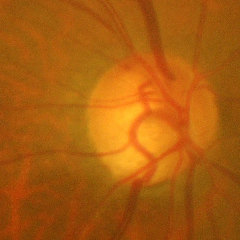
Glaucomatous optic neuropathy is present.
Advanced glaucomatous optic neuropathy.
Diagnostic criteria: near-total cupping of the optic nerve head, with or without severe visual field loss within the central 10 degrees of fixation.